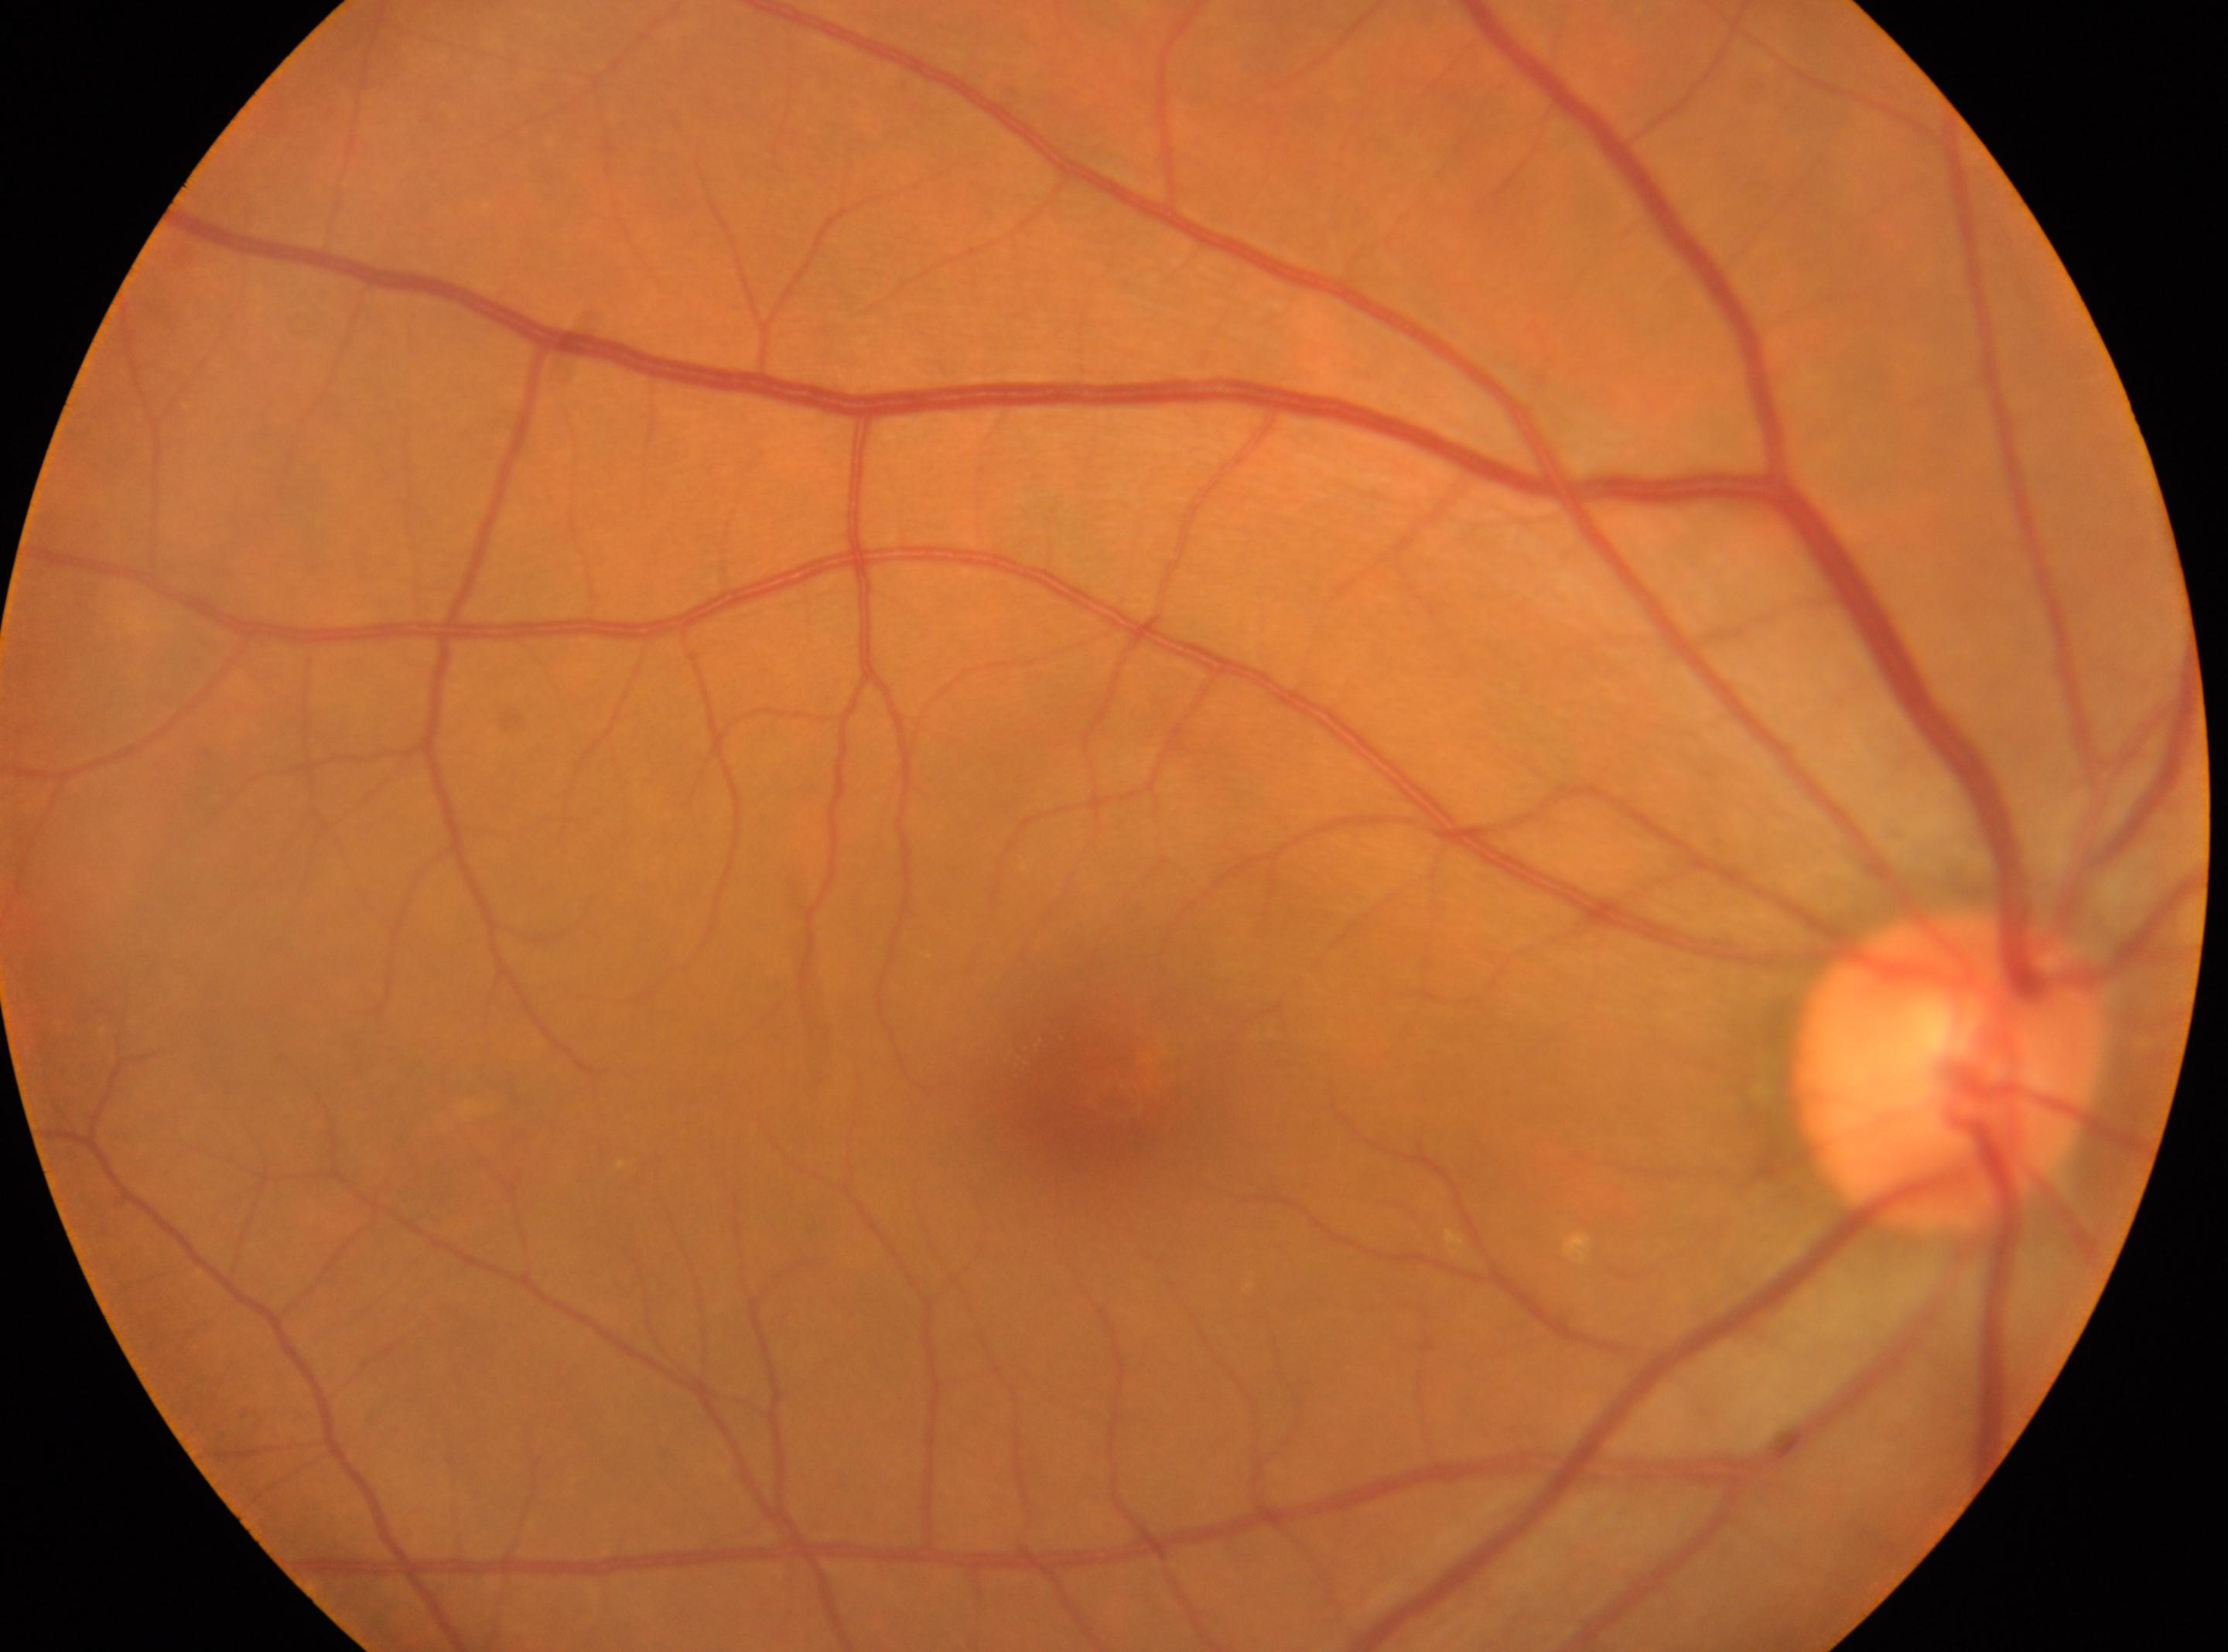

Optic disc located at x=1948, y=1069. The fovea is at x=1112, y=1094. DR grade: no apparent diabetic retinopathy (0). Imaged eye: OD.